Modified Davis grading:
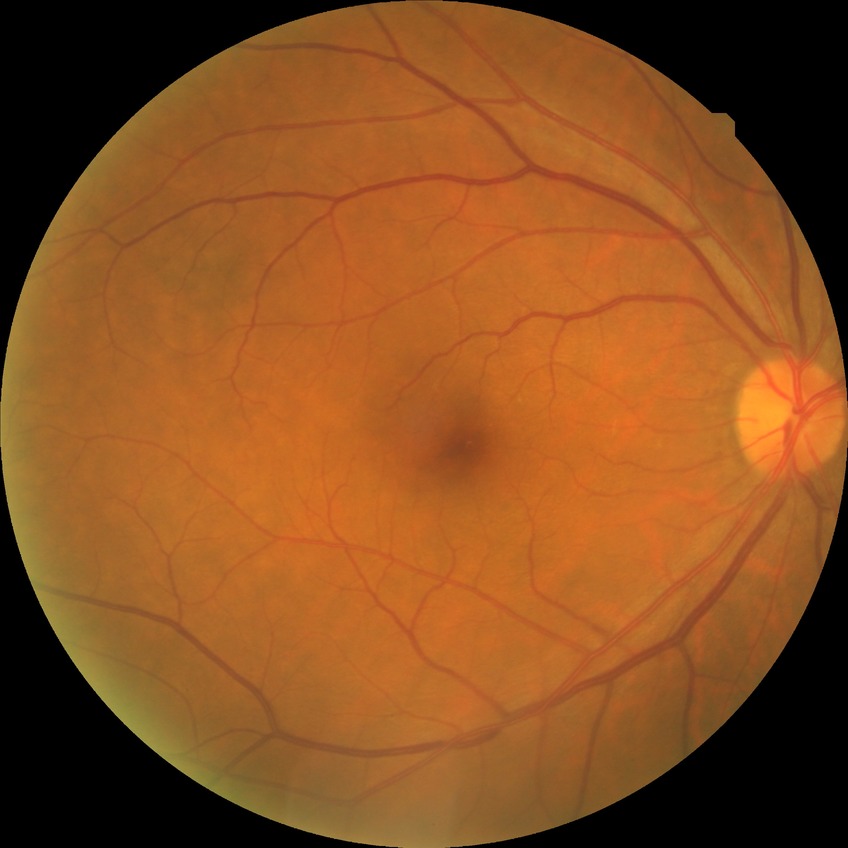

- diabetic retinopathy (DR) — no diabetic retinopathy (NDR)